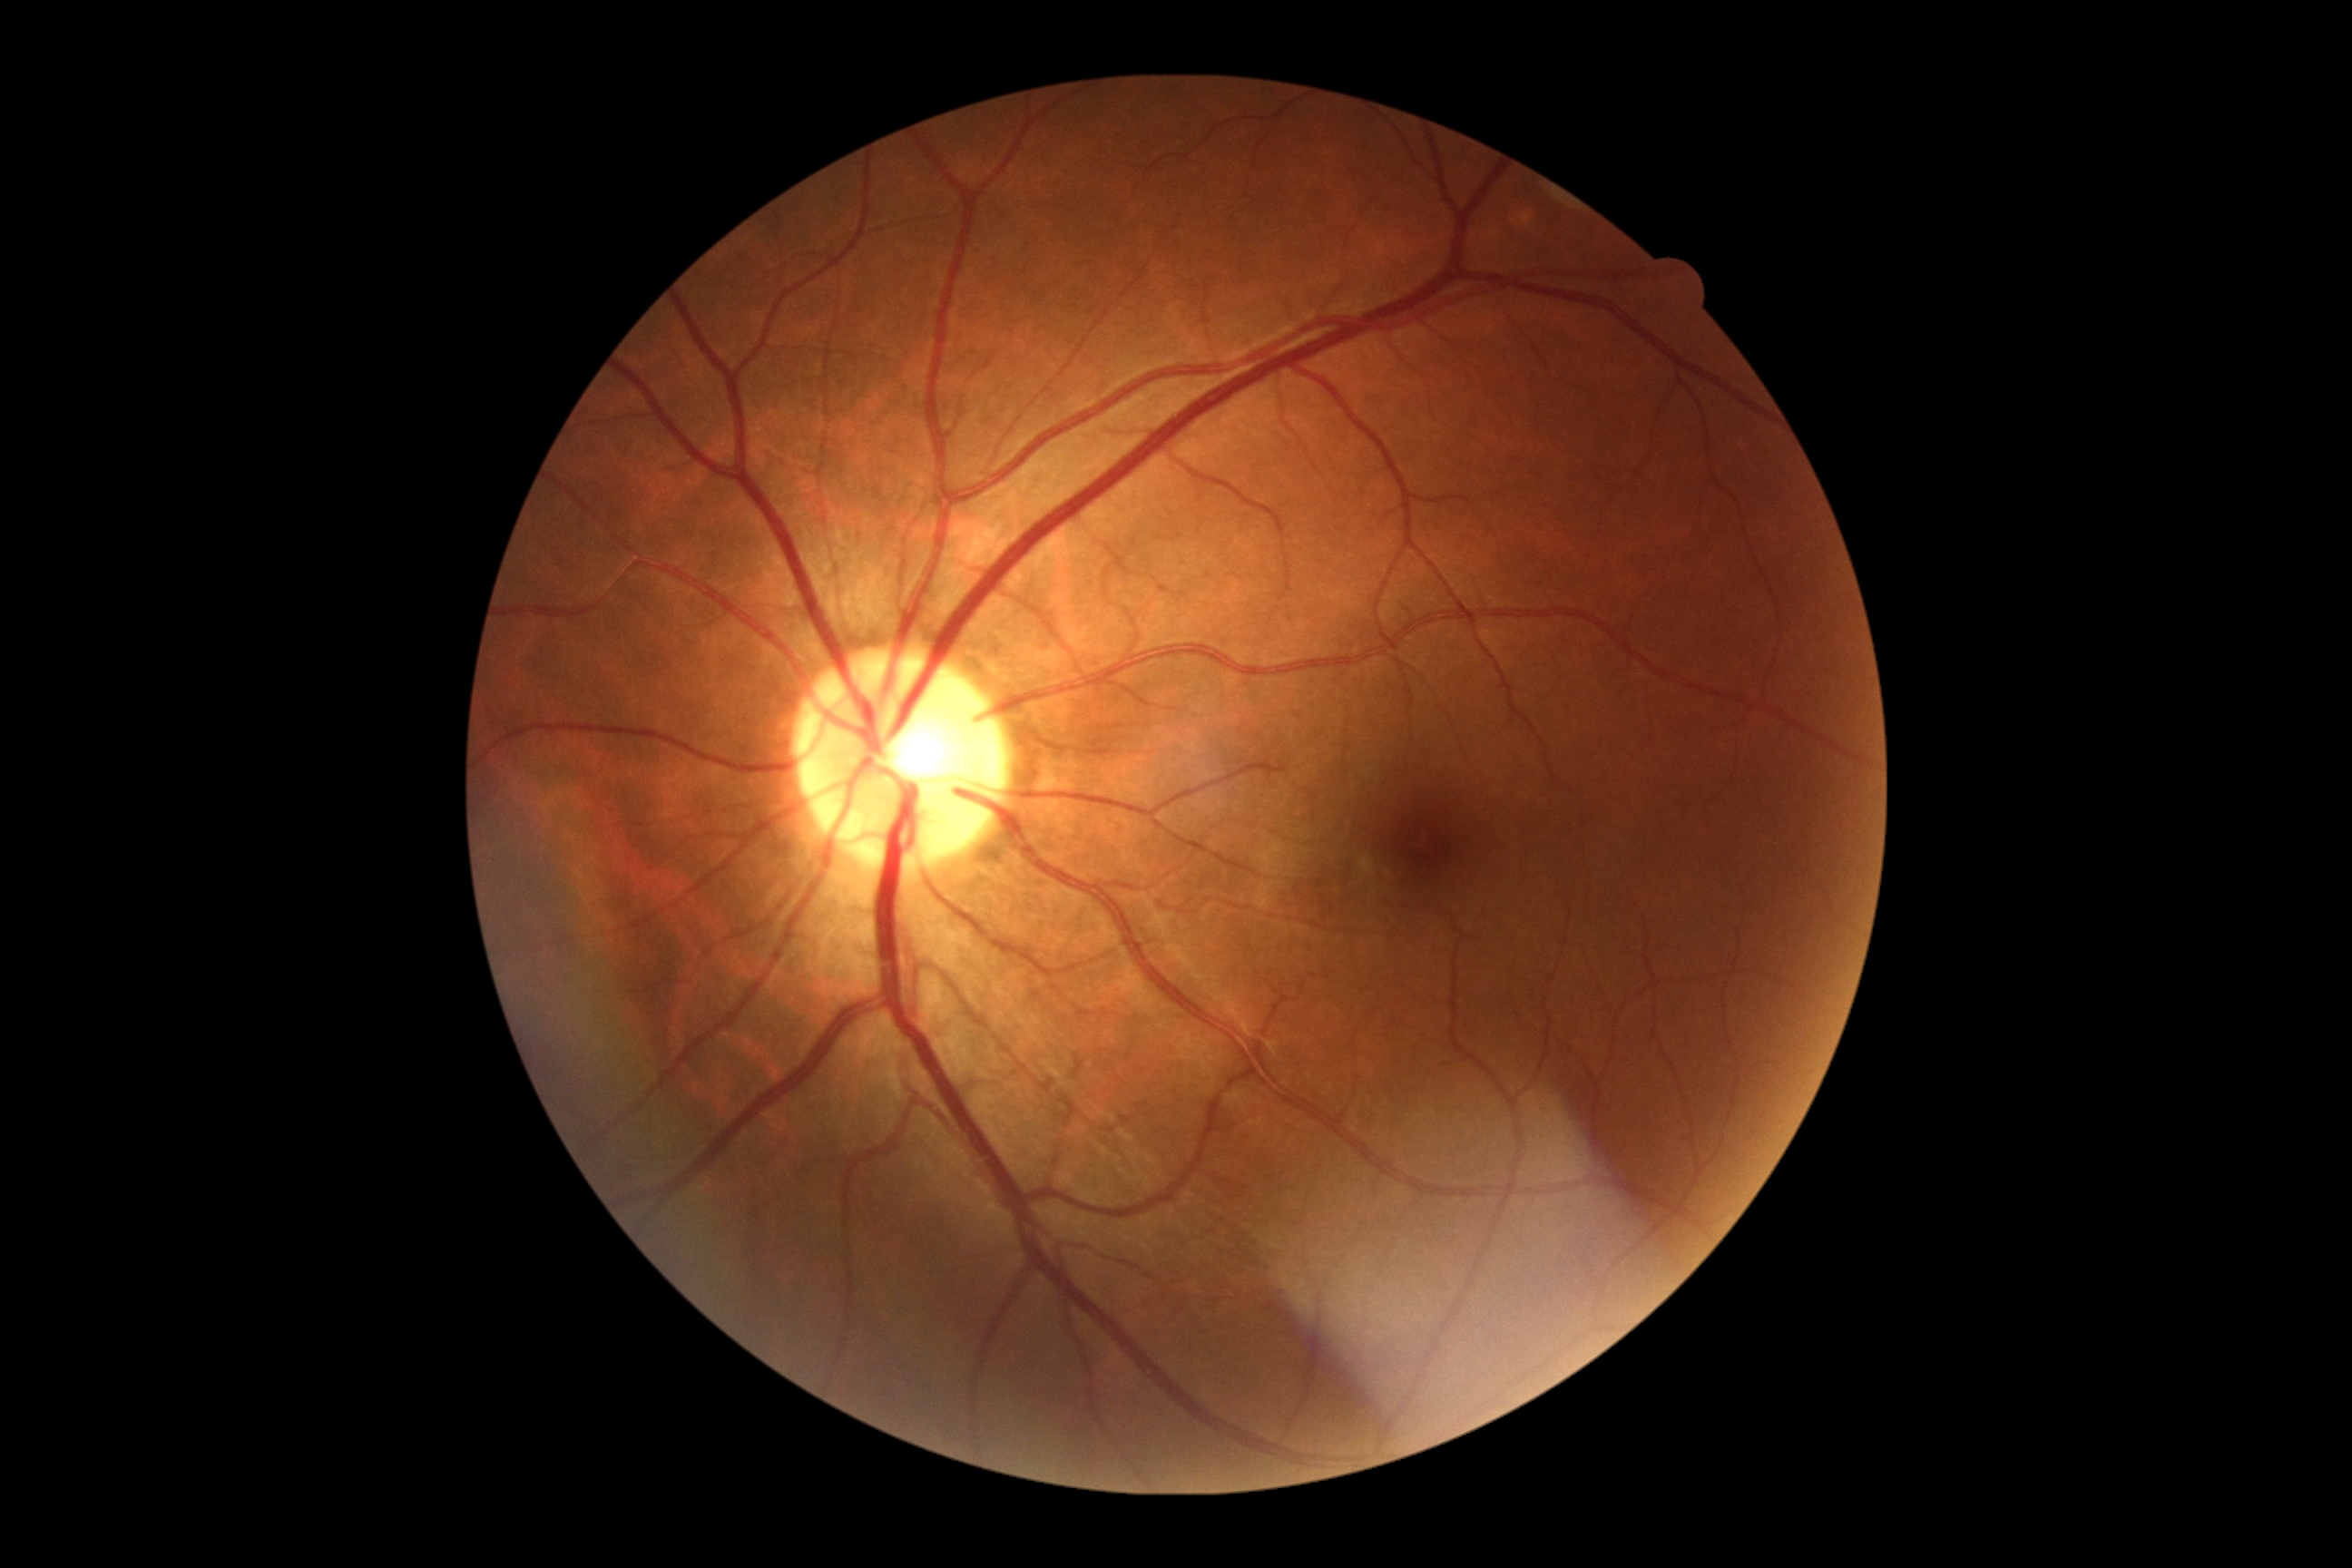 Diabetic retinopathy grade is 0 (no apparent retinopathy).